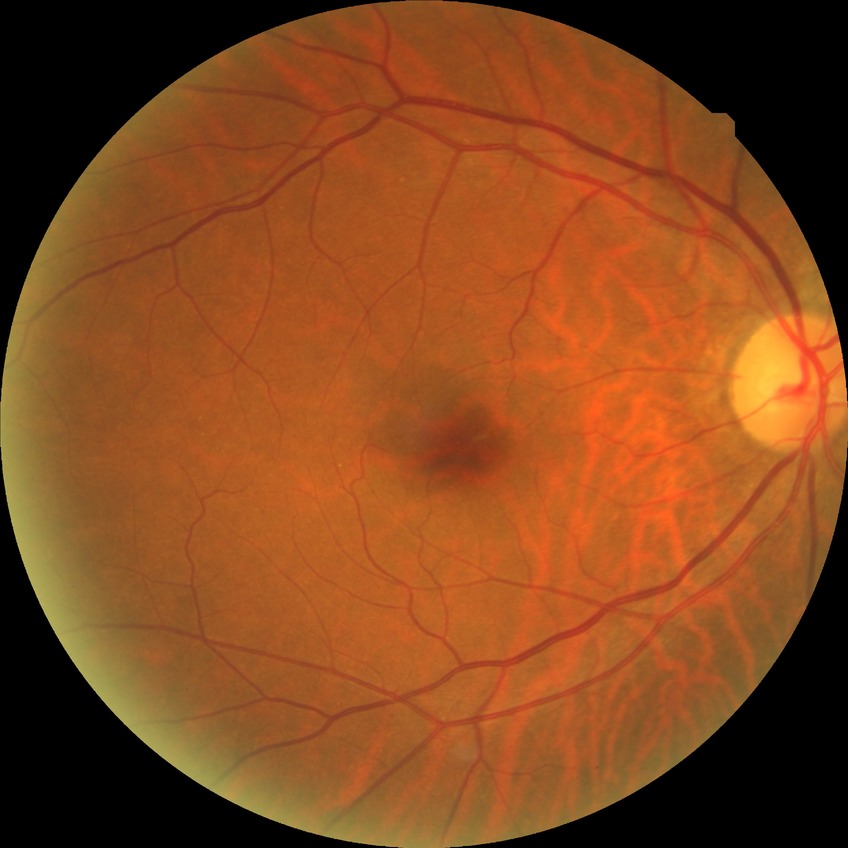
Diabetic retinopathy (DR): no diabetic retinopathy (NDR).